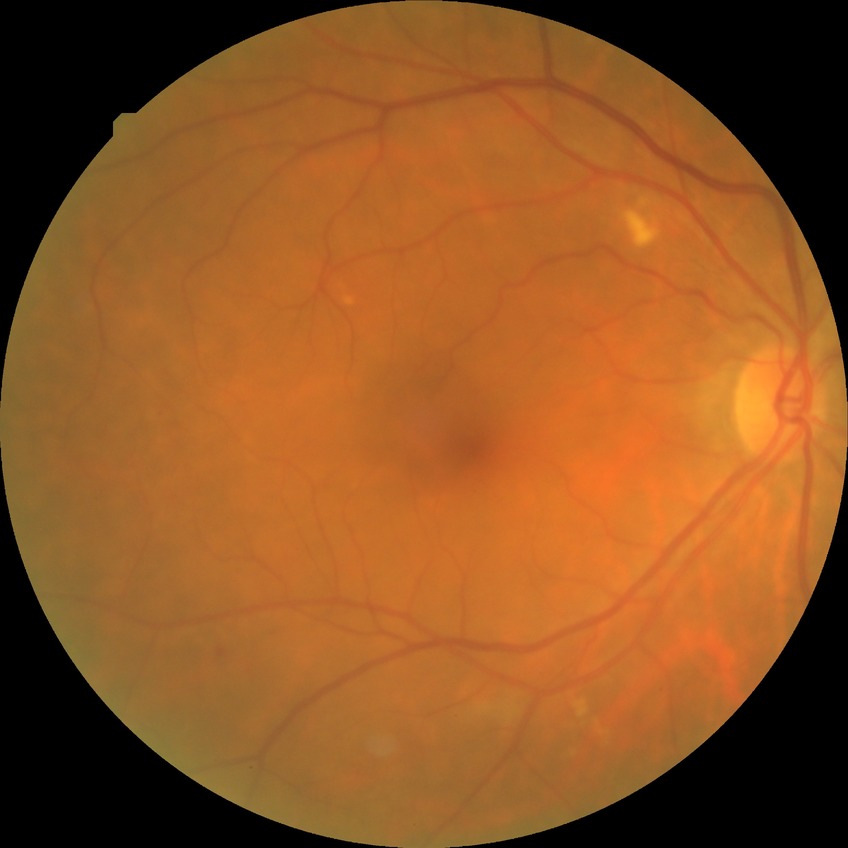
* Davis grading: simple diabetic retinopathy